NIDEK AFC-230
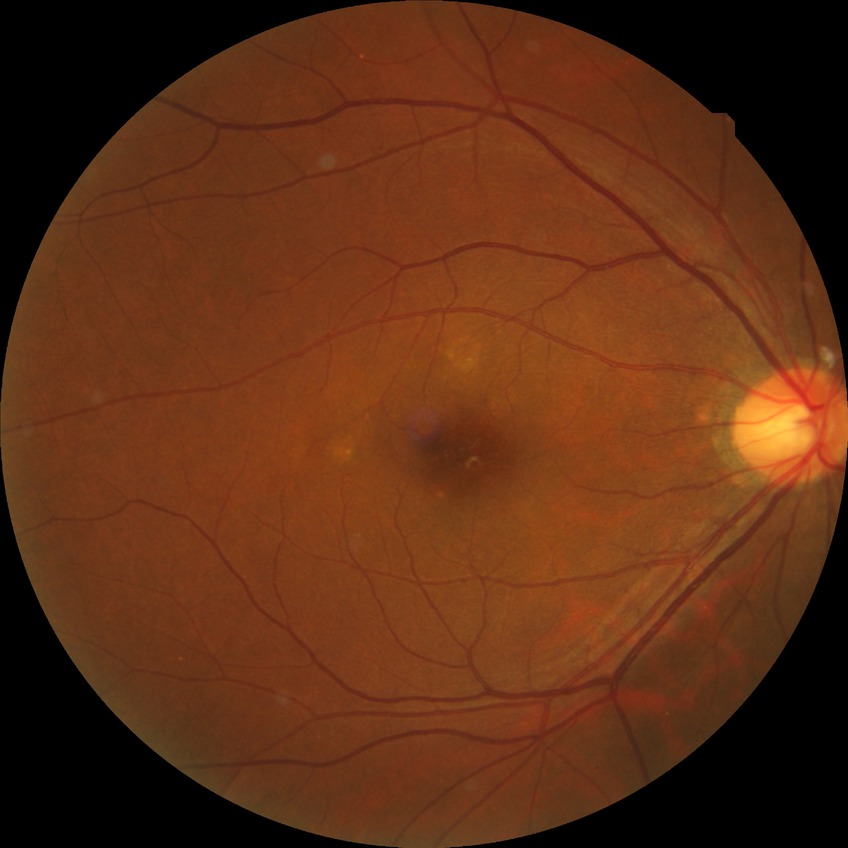   davis_grade: NDR (no diabetic retinopathy)